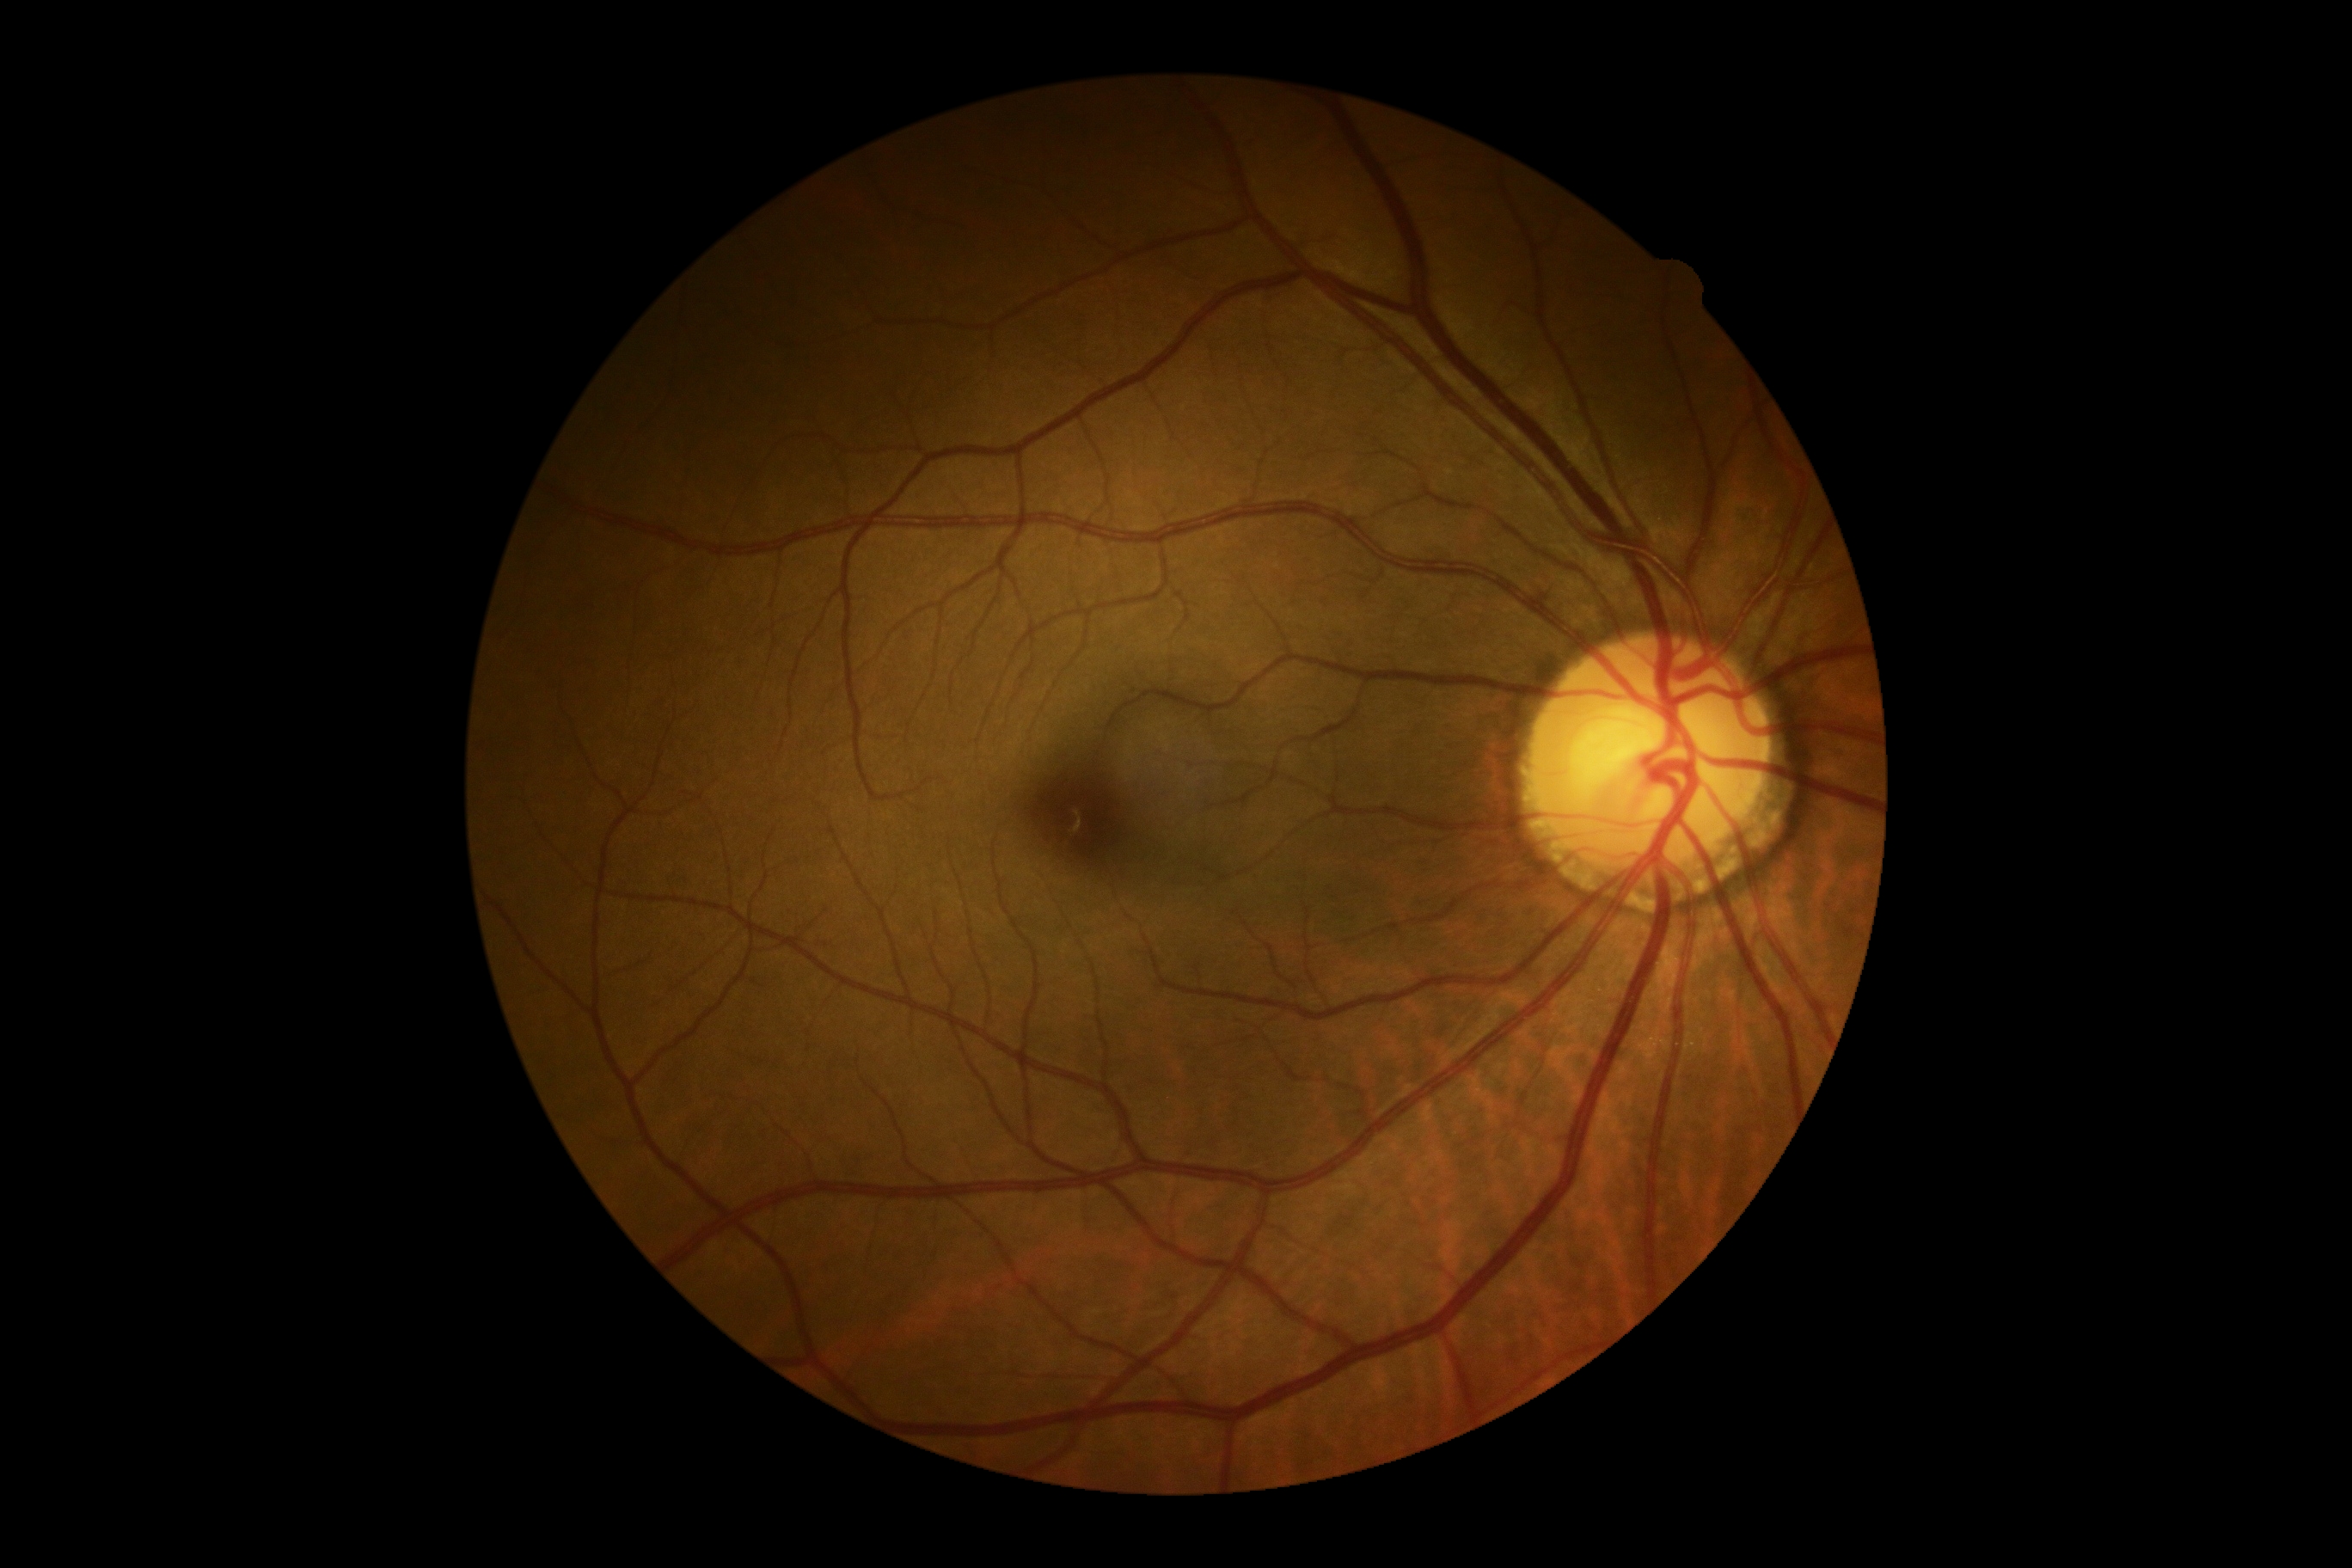
retinopathy grade = 0.